1240 x 1240 pixels; 100° field of view (Phoenix ICON); infant wide-field fundus photograph: 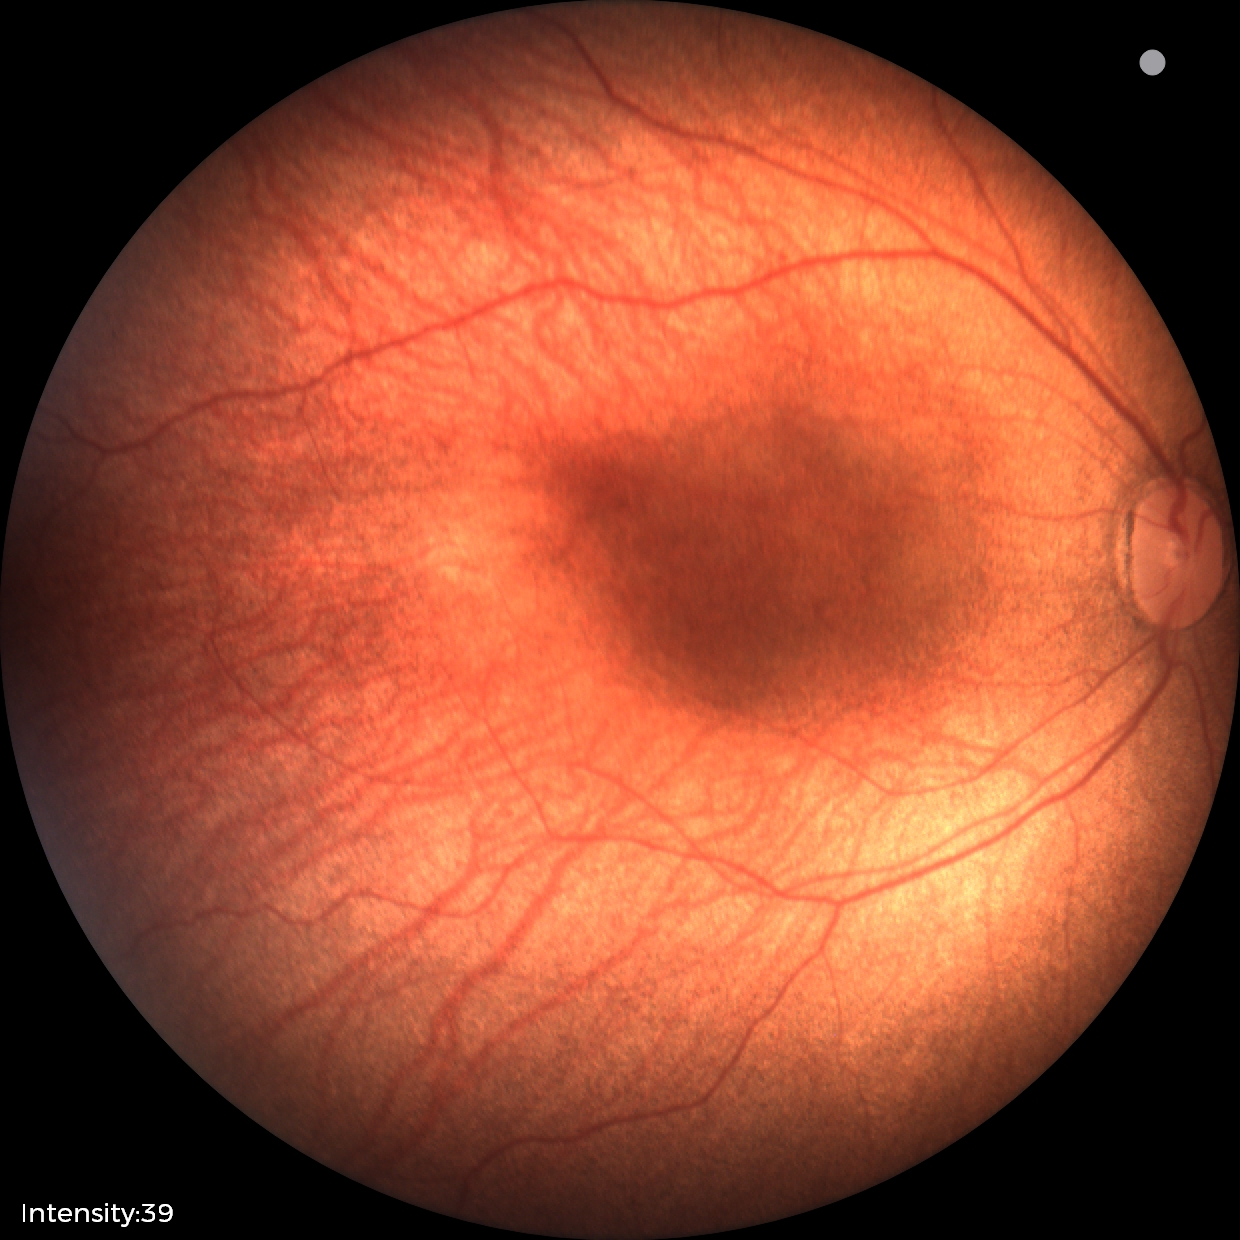
Series diagnosed as status post retinopathy of prematurity (ROP). Plus disease absent.